45° FOV
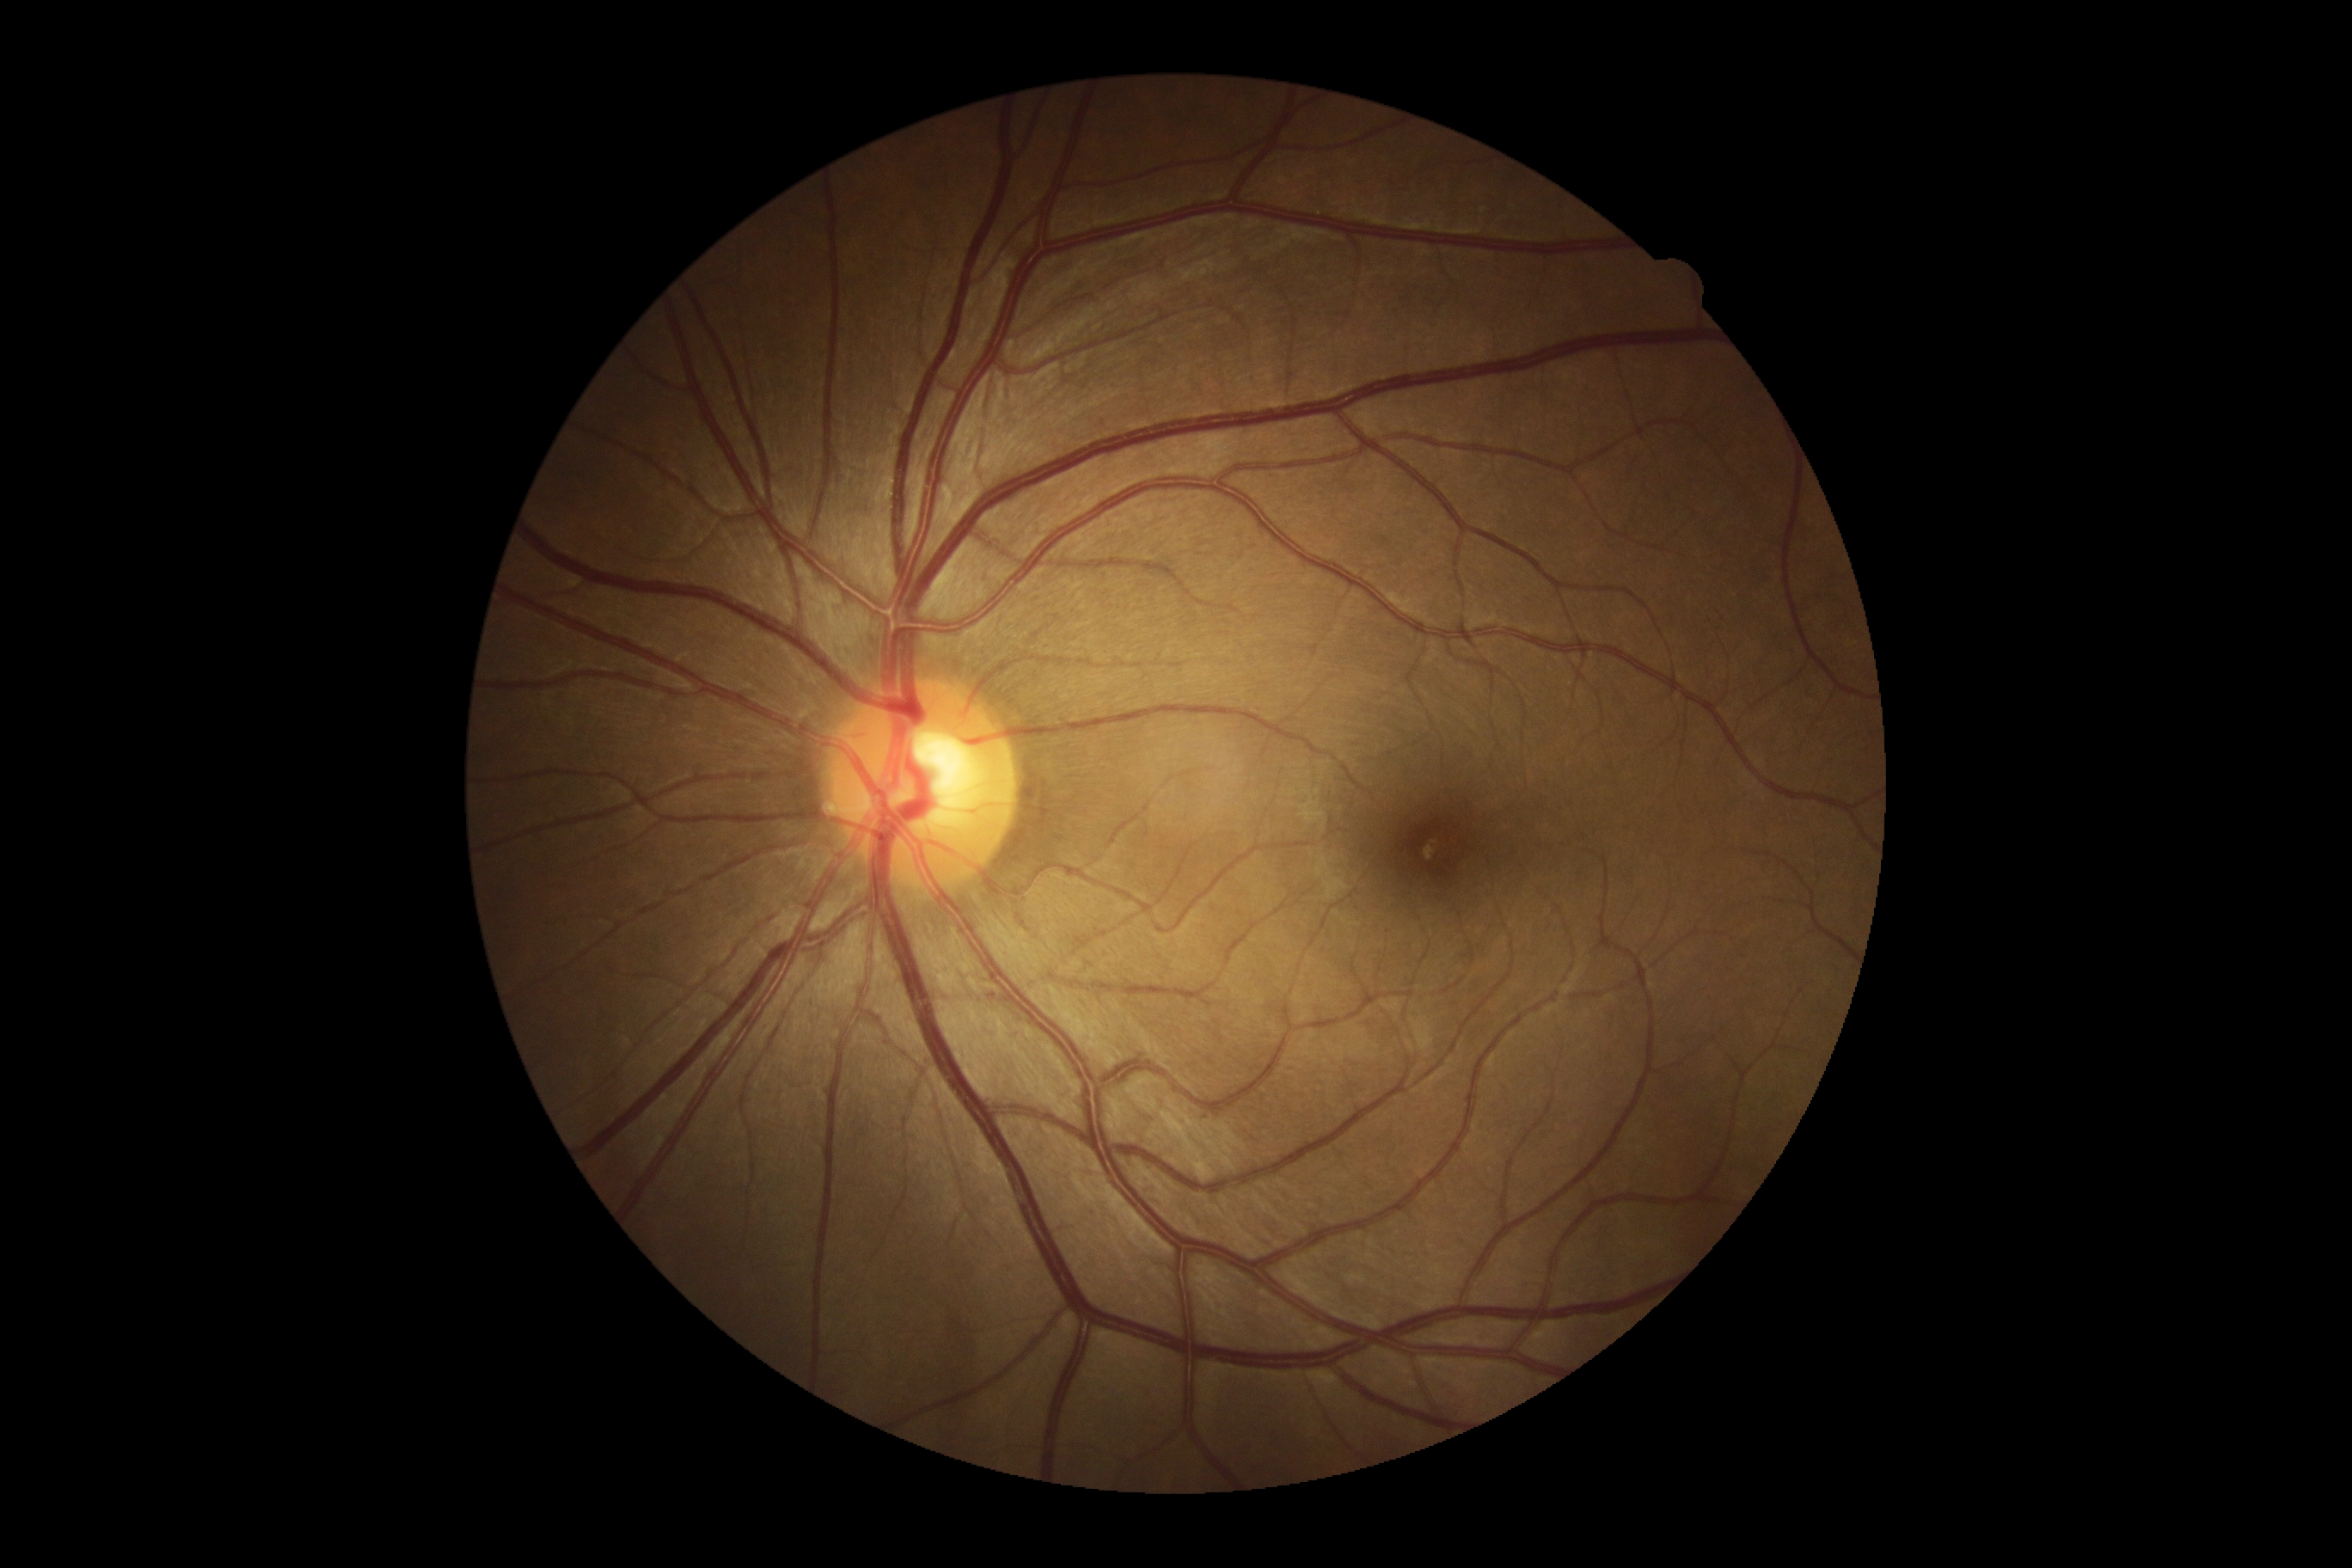
No signs of diabetic retinopathy. Diabetic retinopathy is grade 0 (no apparent retinopathy) — no visible signs of diabetic retinopathy.